640 by 480 pixels. Wide-field fundus photograph from neonatal ROP screening
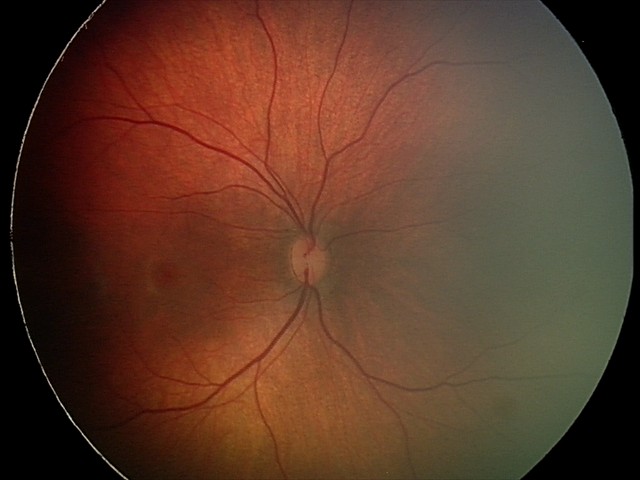 From an examination with diagnosis of retinal hemorrhages.